45-degree field of view:
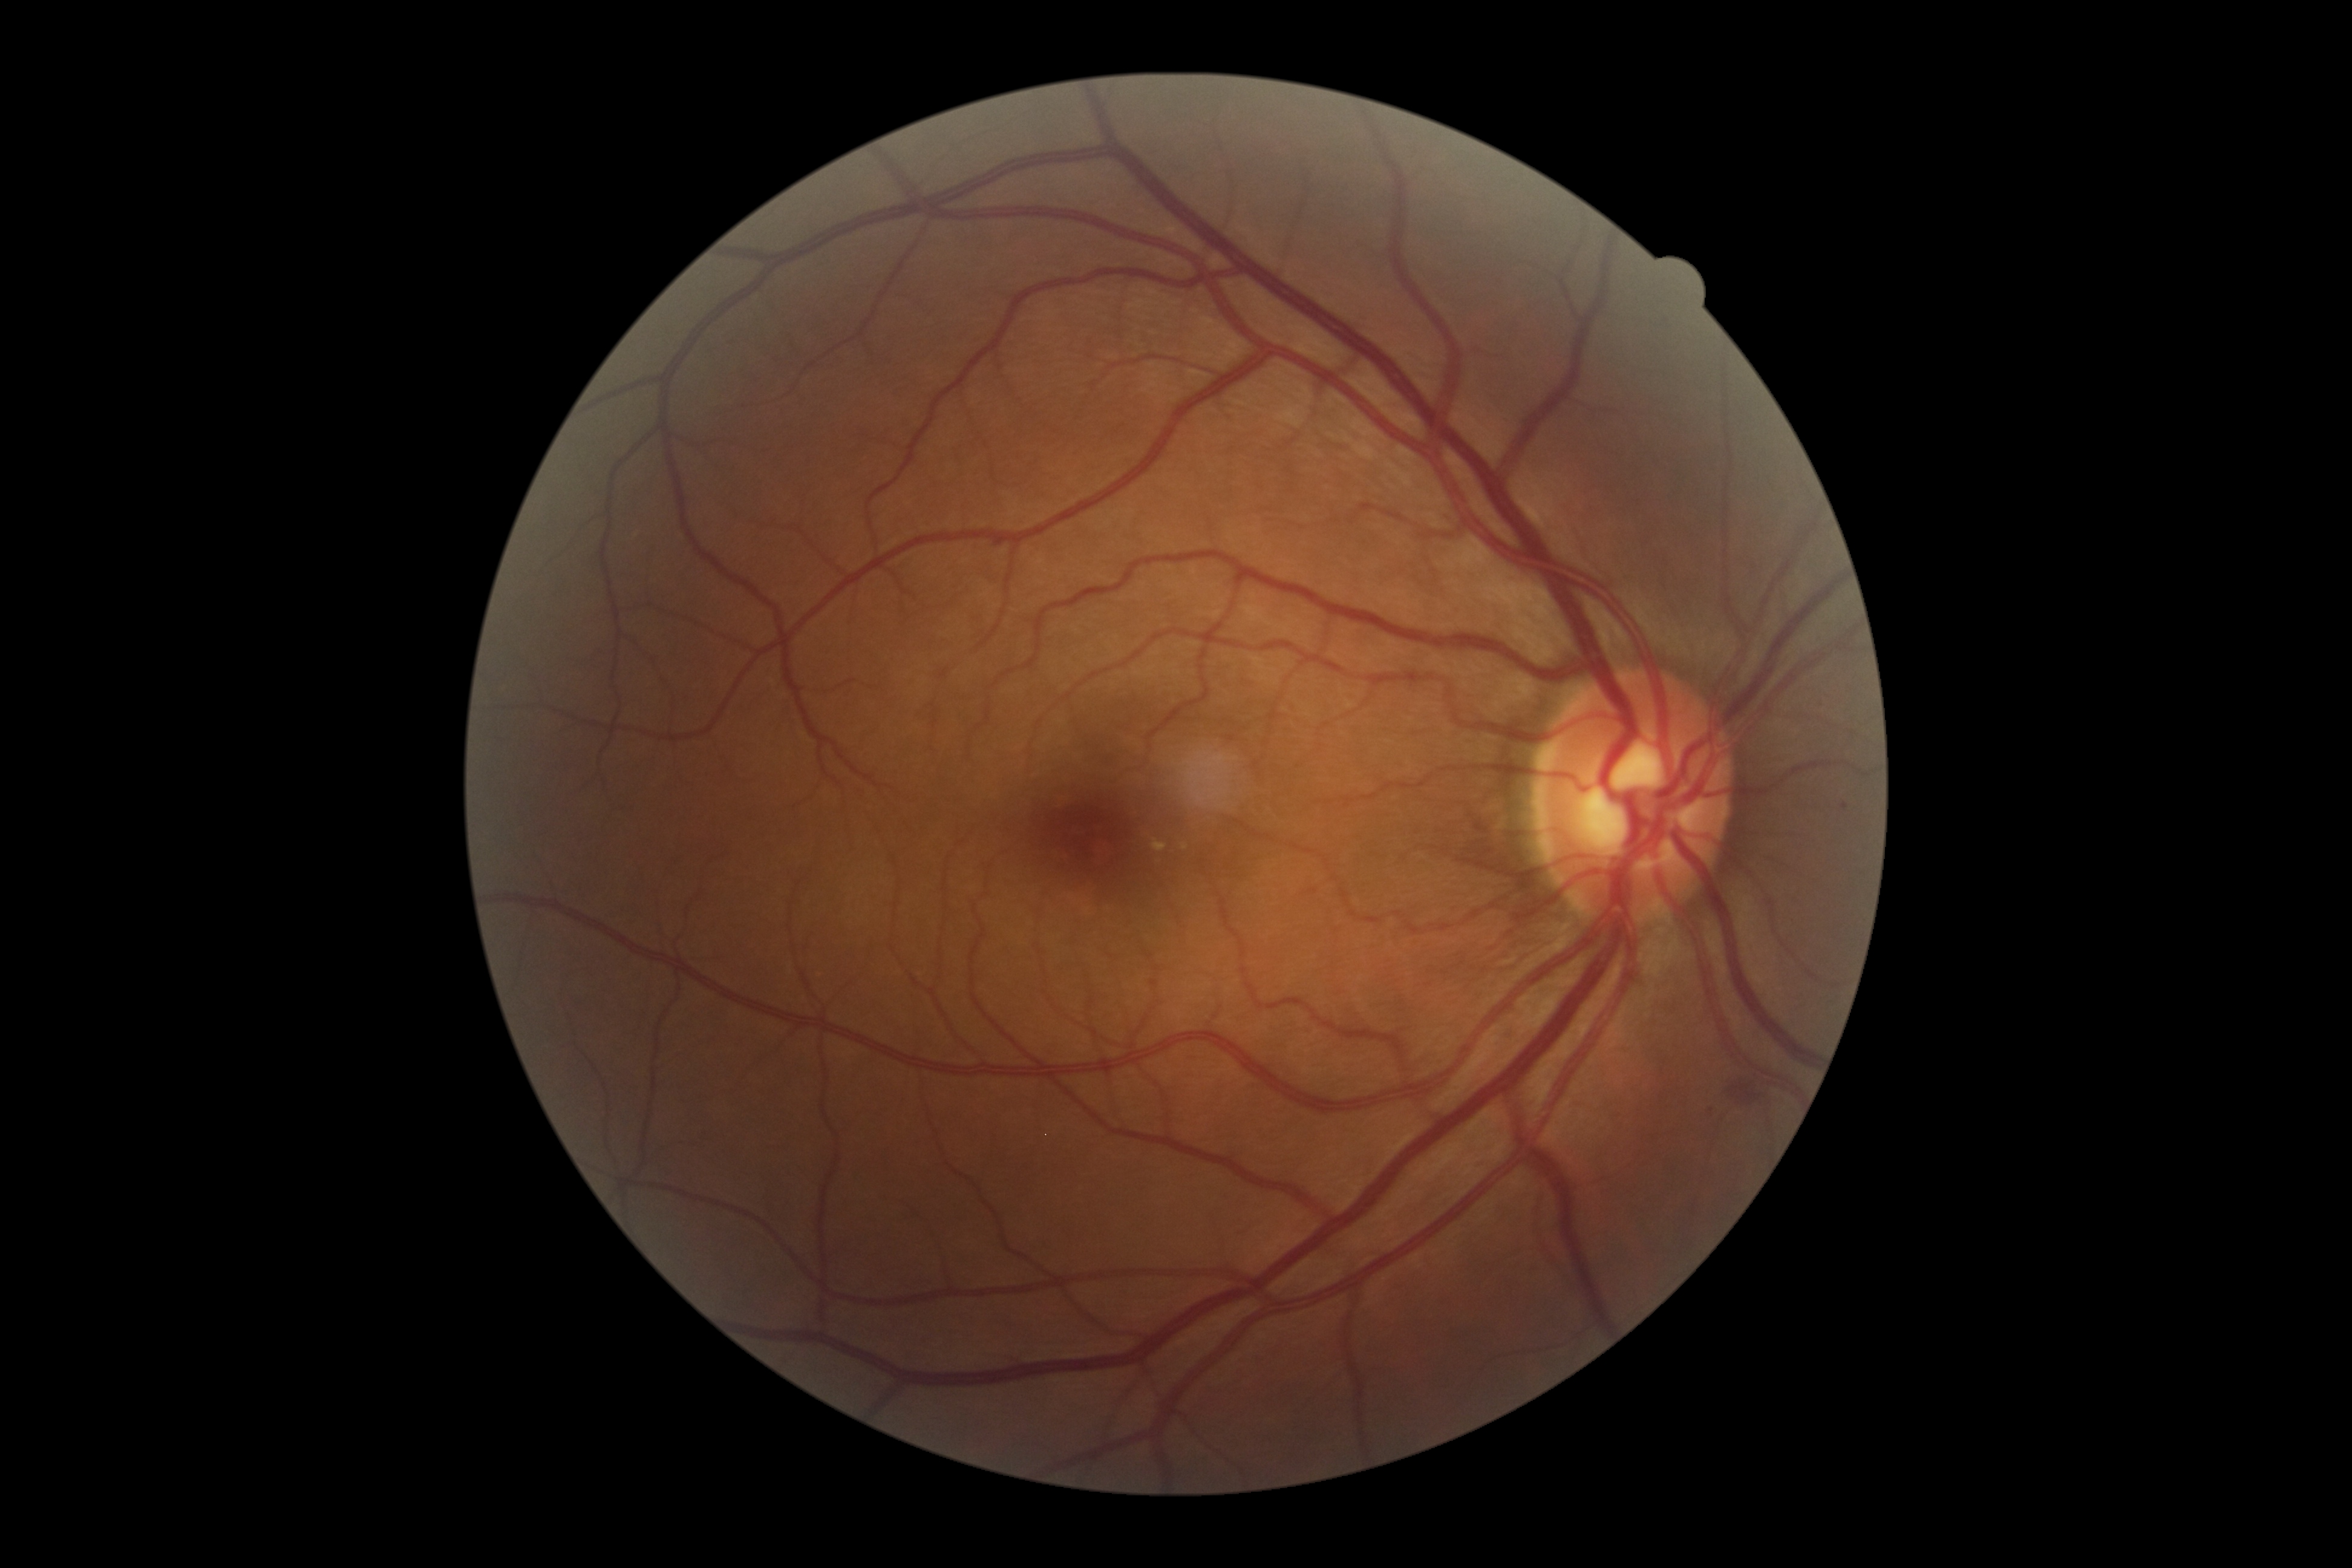

DR: grade 2 (moderate NPDR).
Disease class: non-proliferative diabetic retinopathy.